Captured with the Phoenix ICON (100° field of view); infant wide-field fundus photograph — 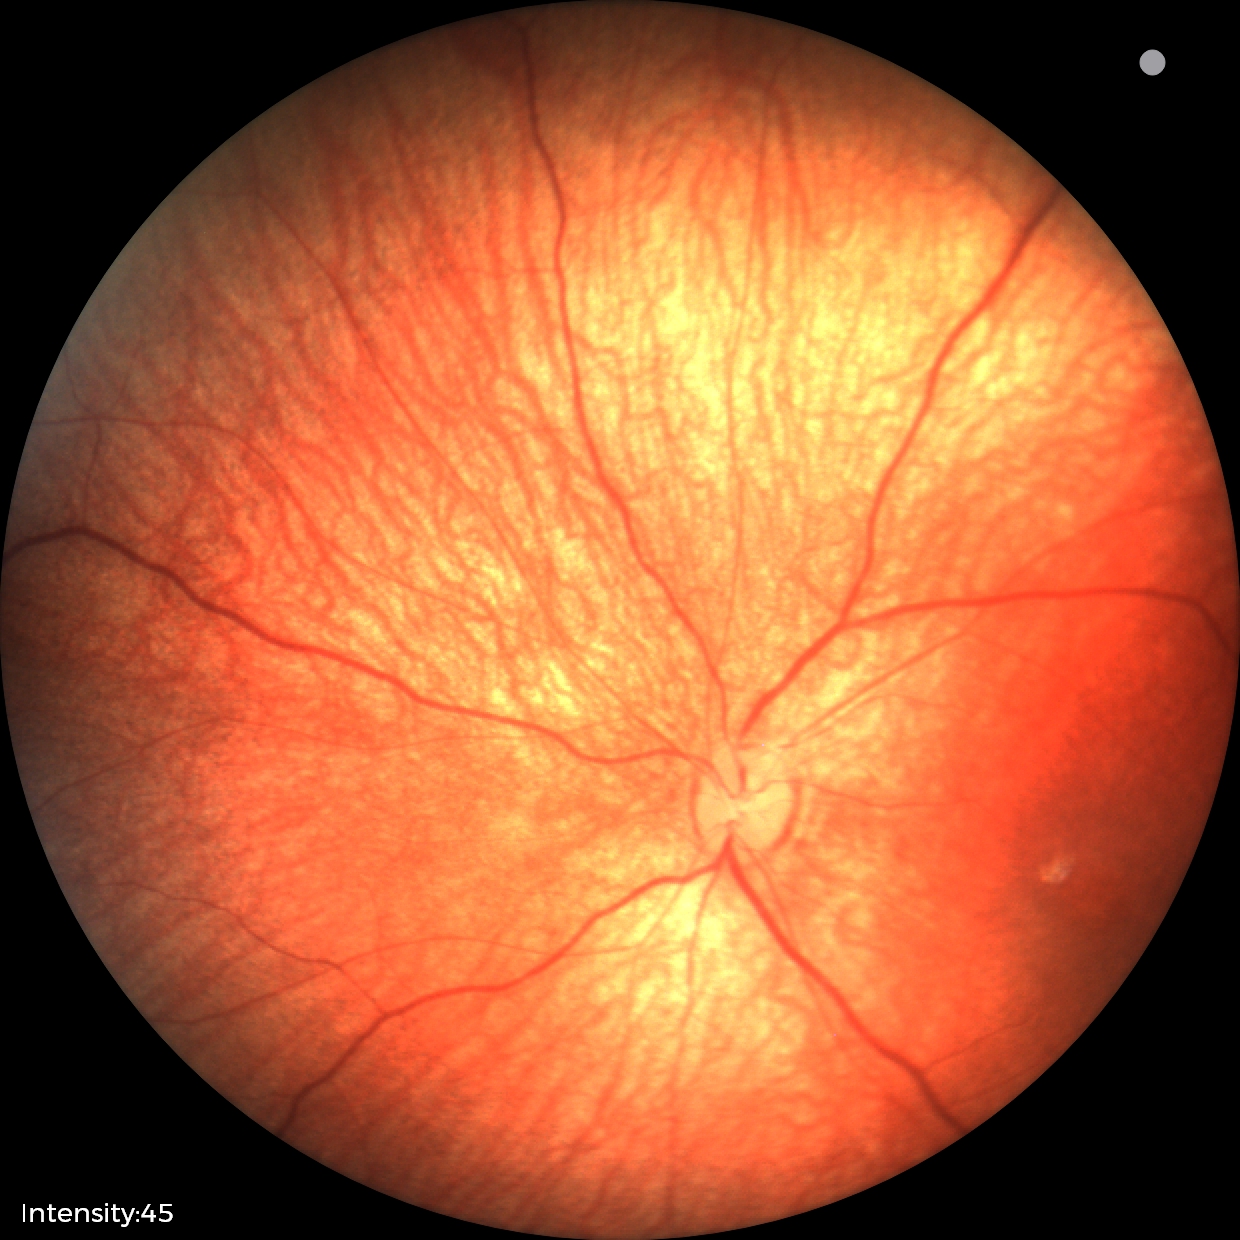 Assessment: normal fundus examination.